Posterior pole view: 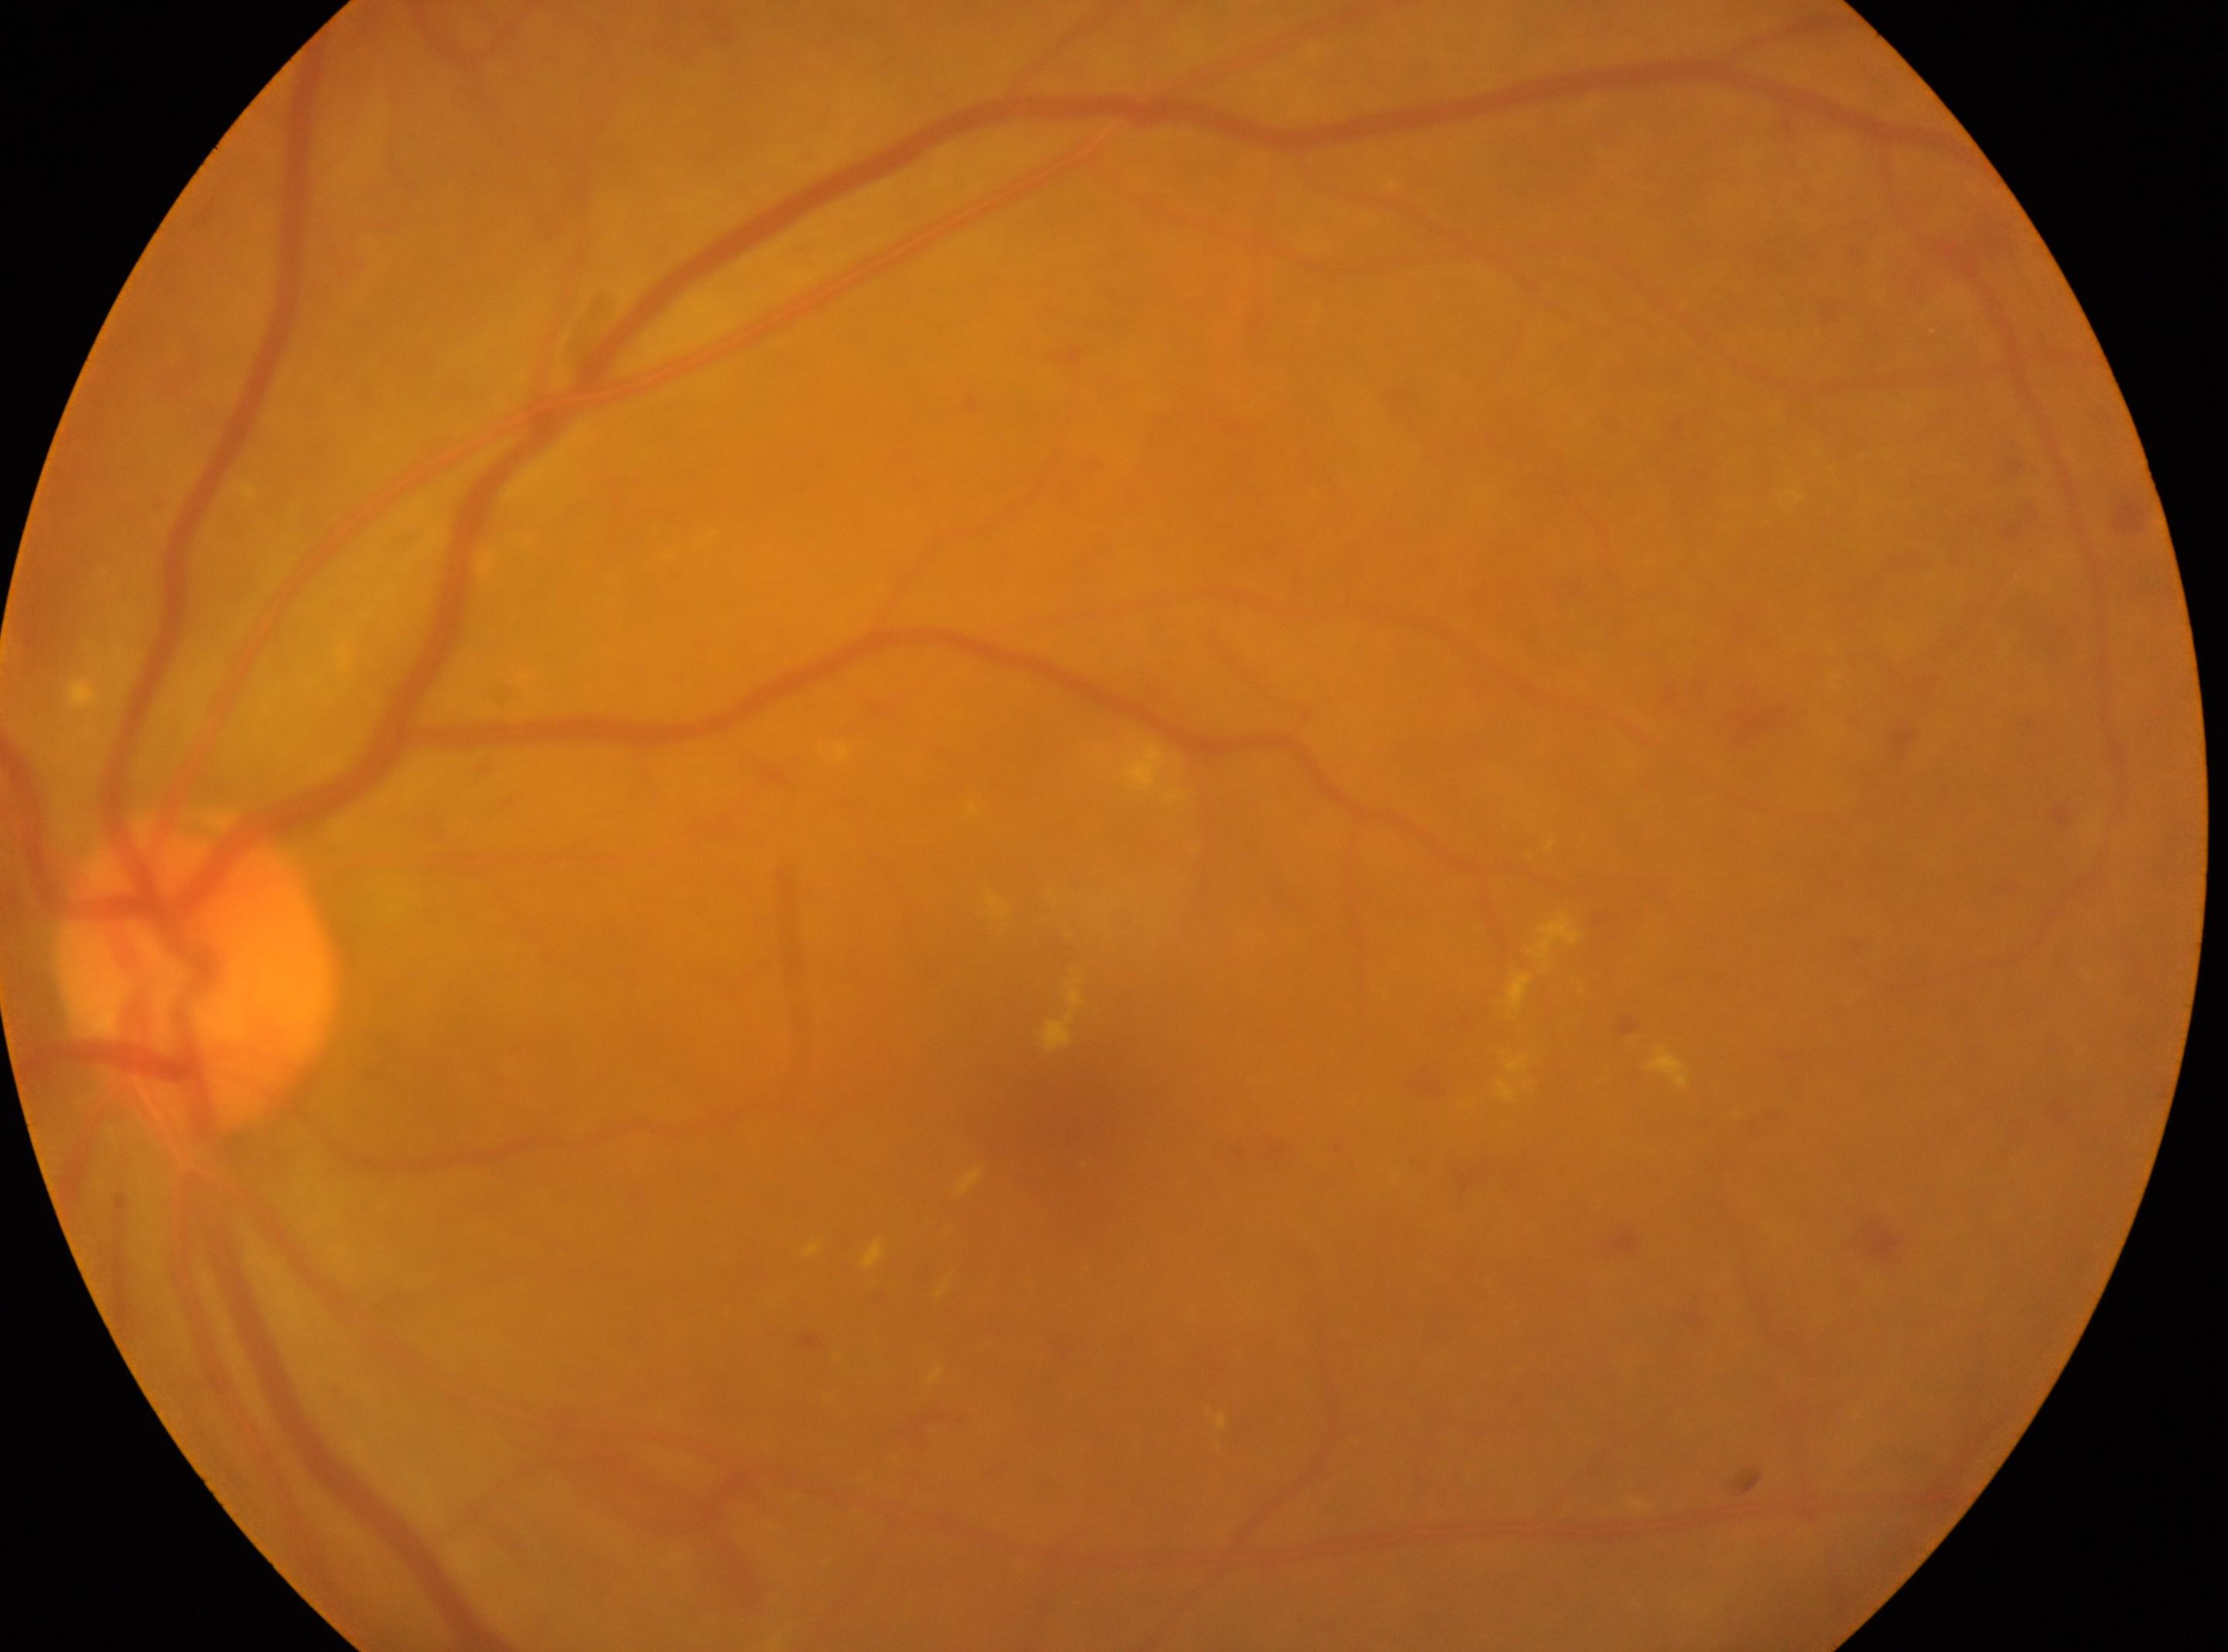
The fovea is at (1052, 1109). Eye: left eye. Diabetic retinopathy (DR) is 2/4. Optic nerve head located at (196, 968).